Nonmydriatic fundus photograph
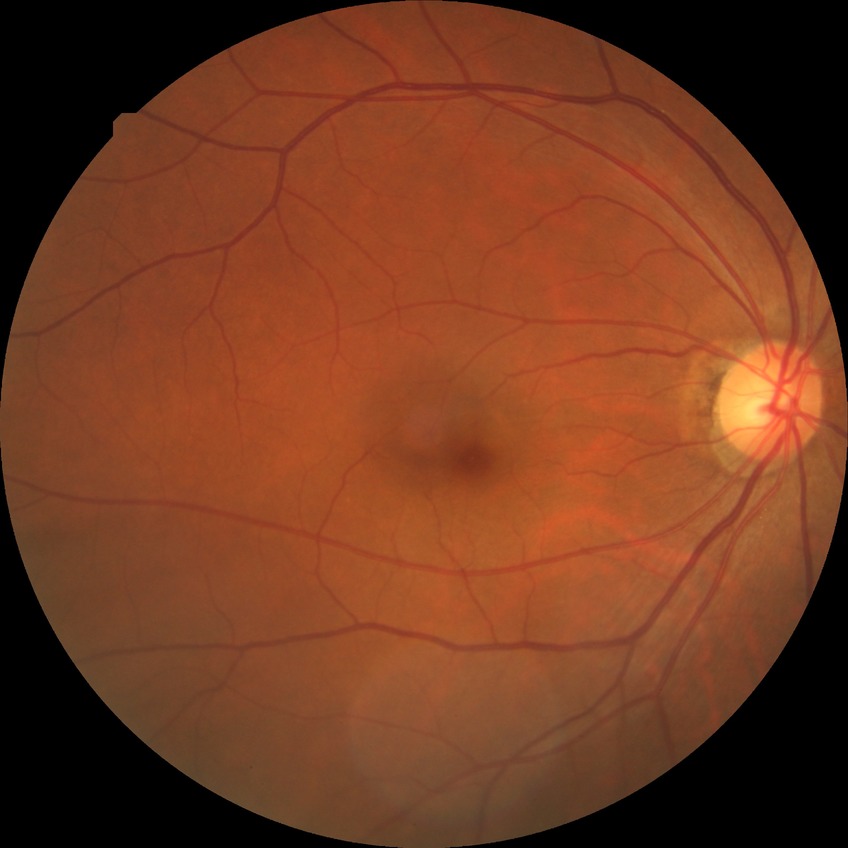
Diabetic retinopathy (DR): no diabetic retinopathy (NDR).